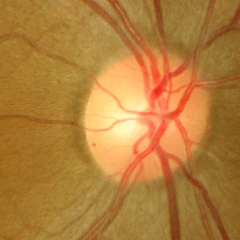
No glaucomatous optic neuropathy.